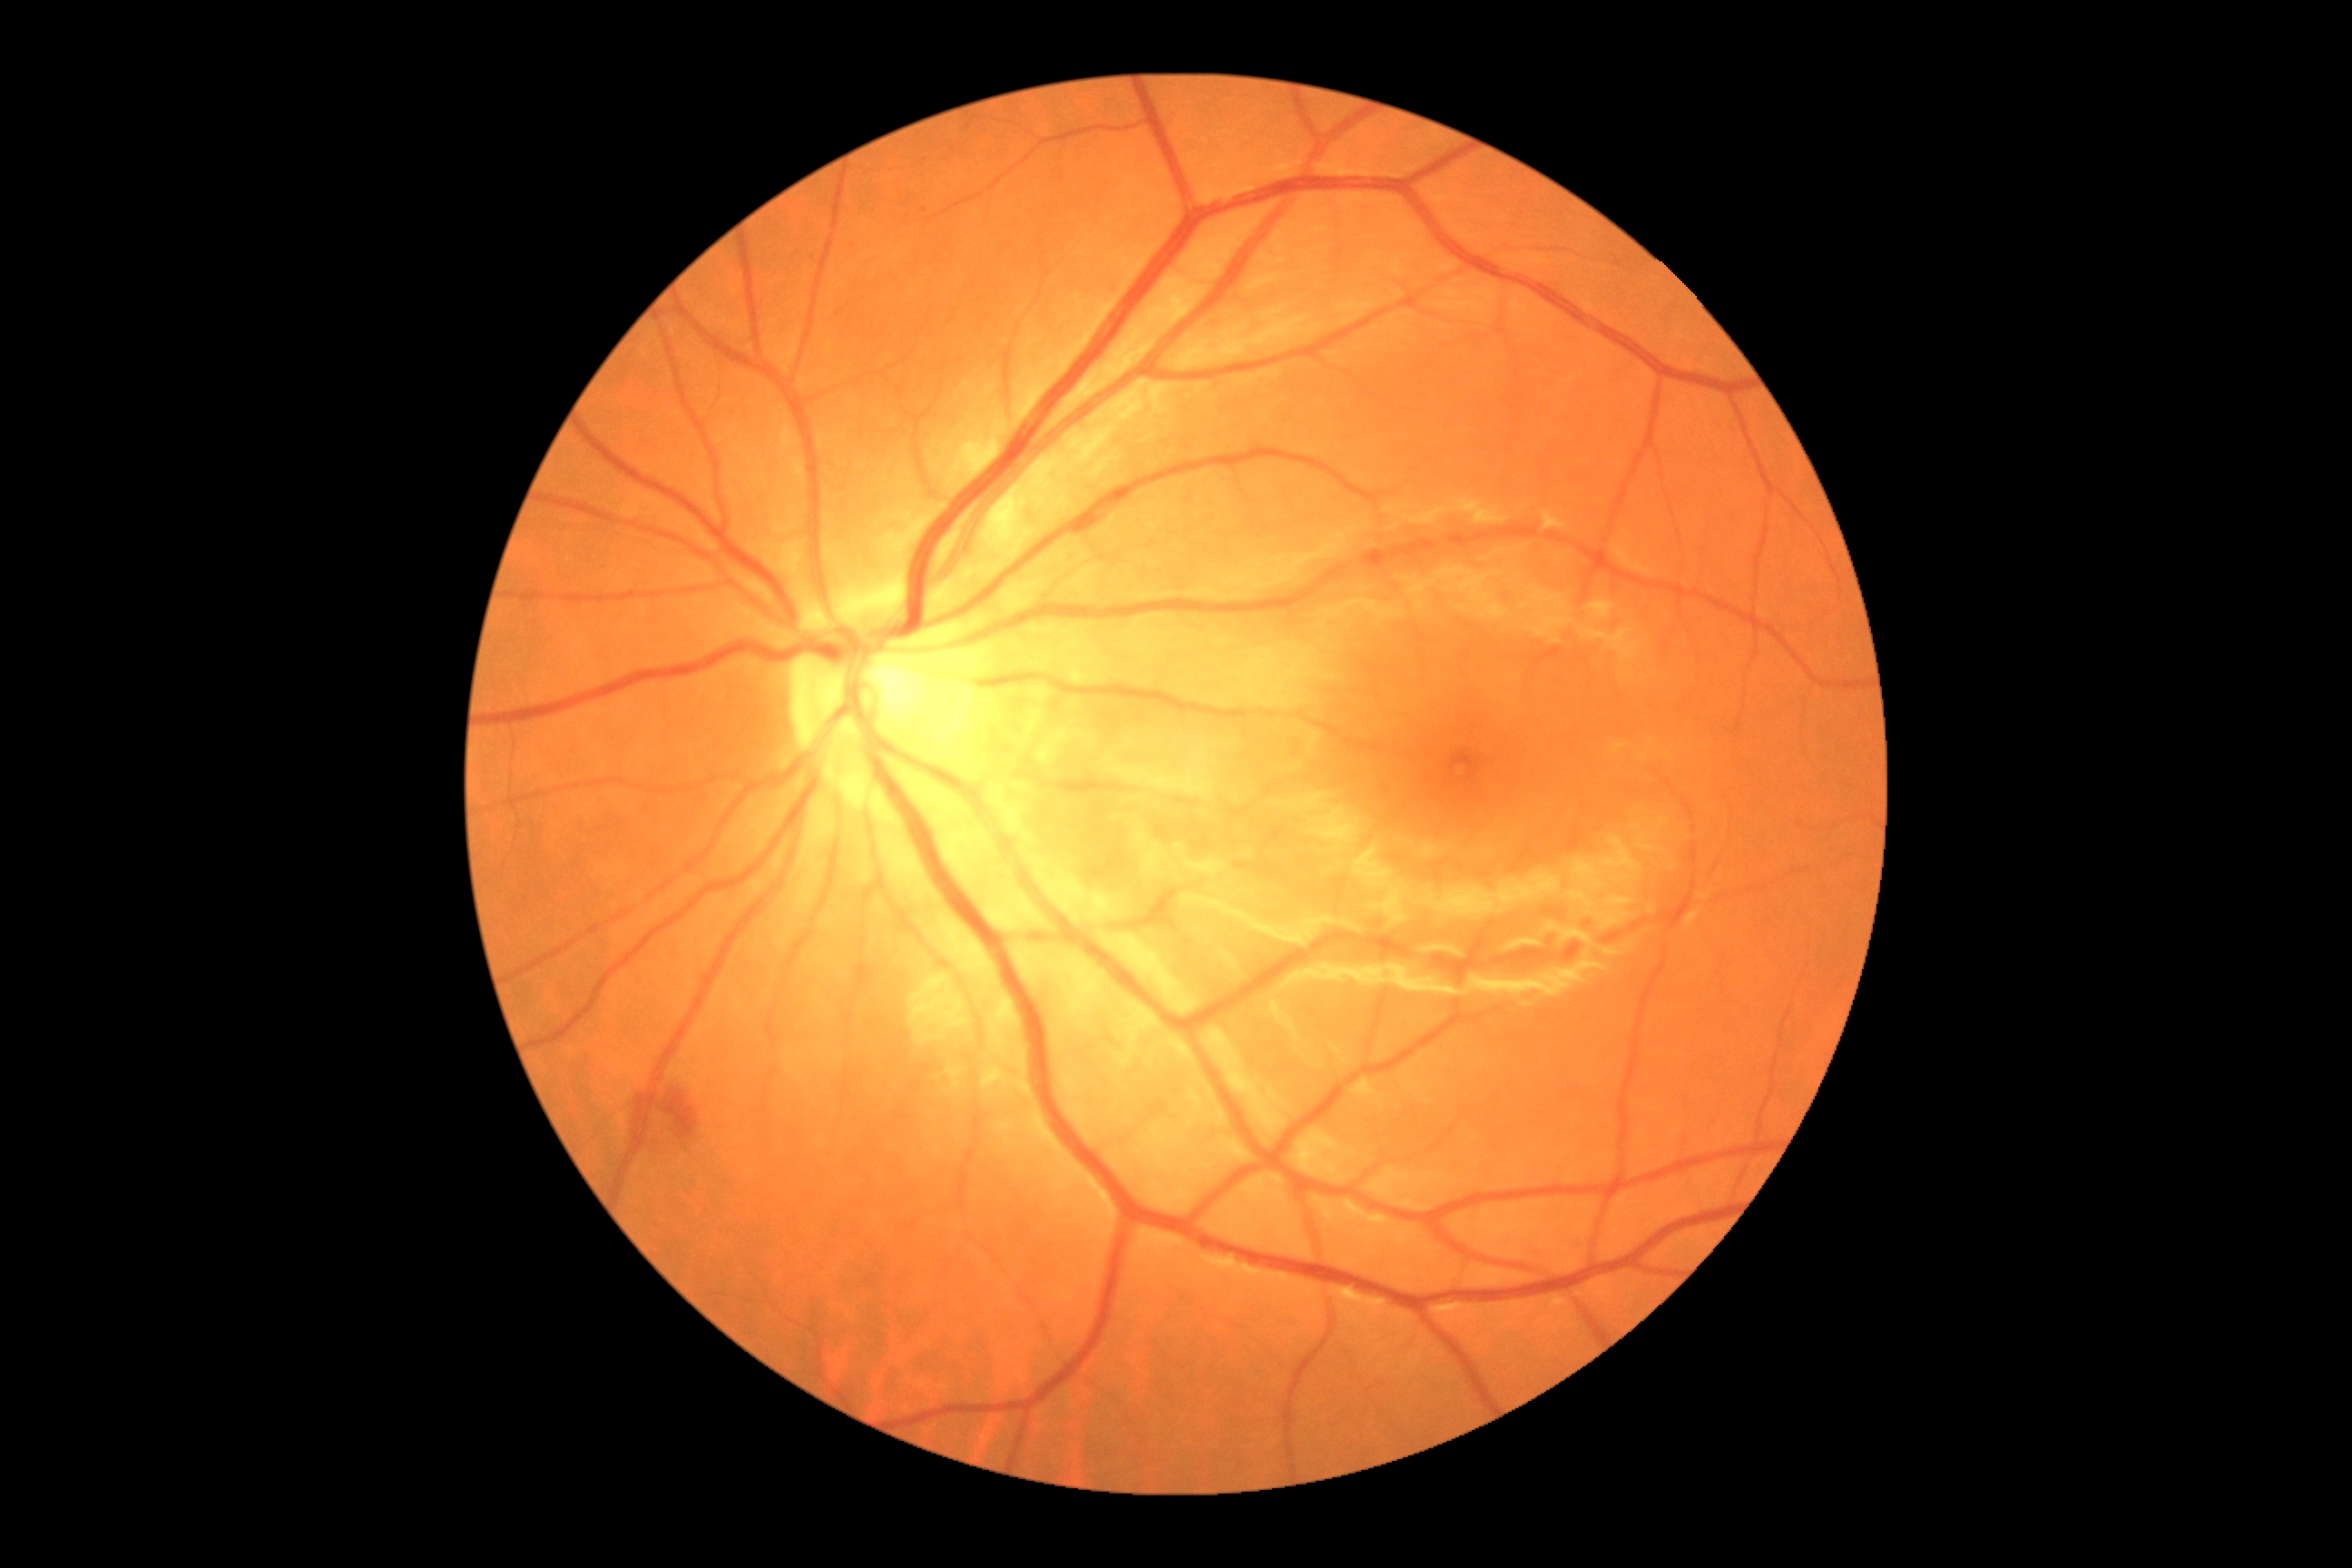
{
  "dr_grade": "2"
}